Wide-field fundus image from infant ROP screening
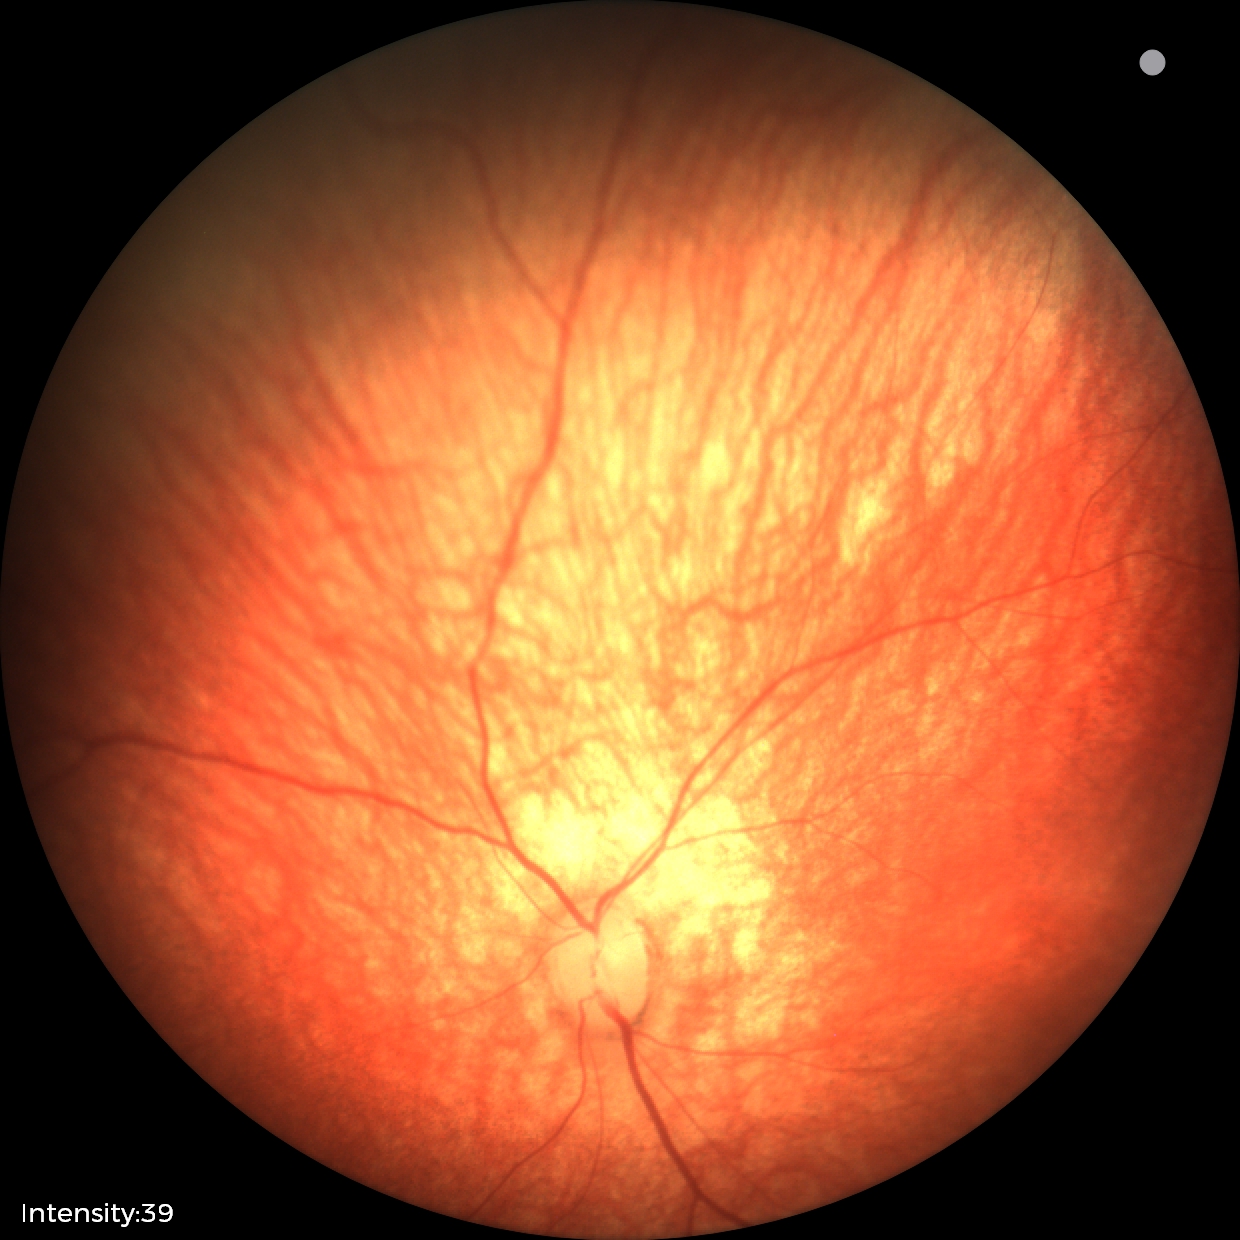 Impression: normal fundus examination.